Color fundus image — 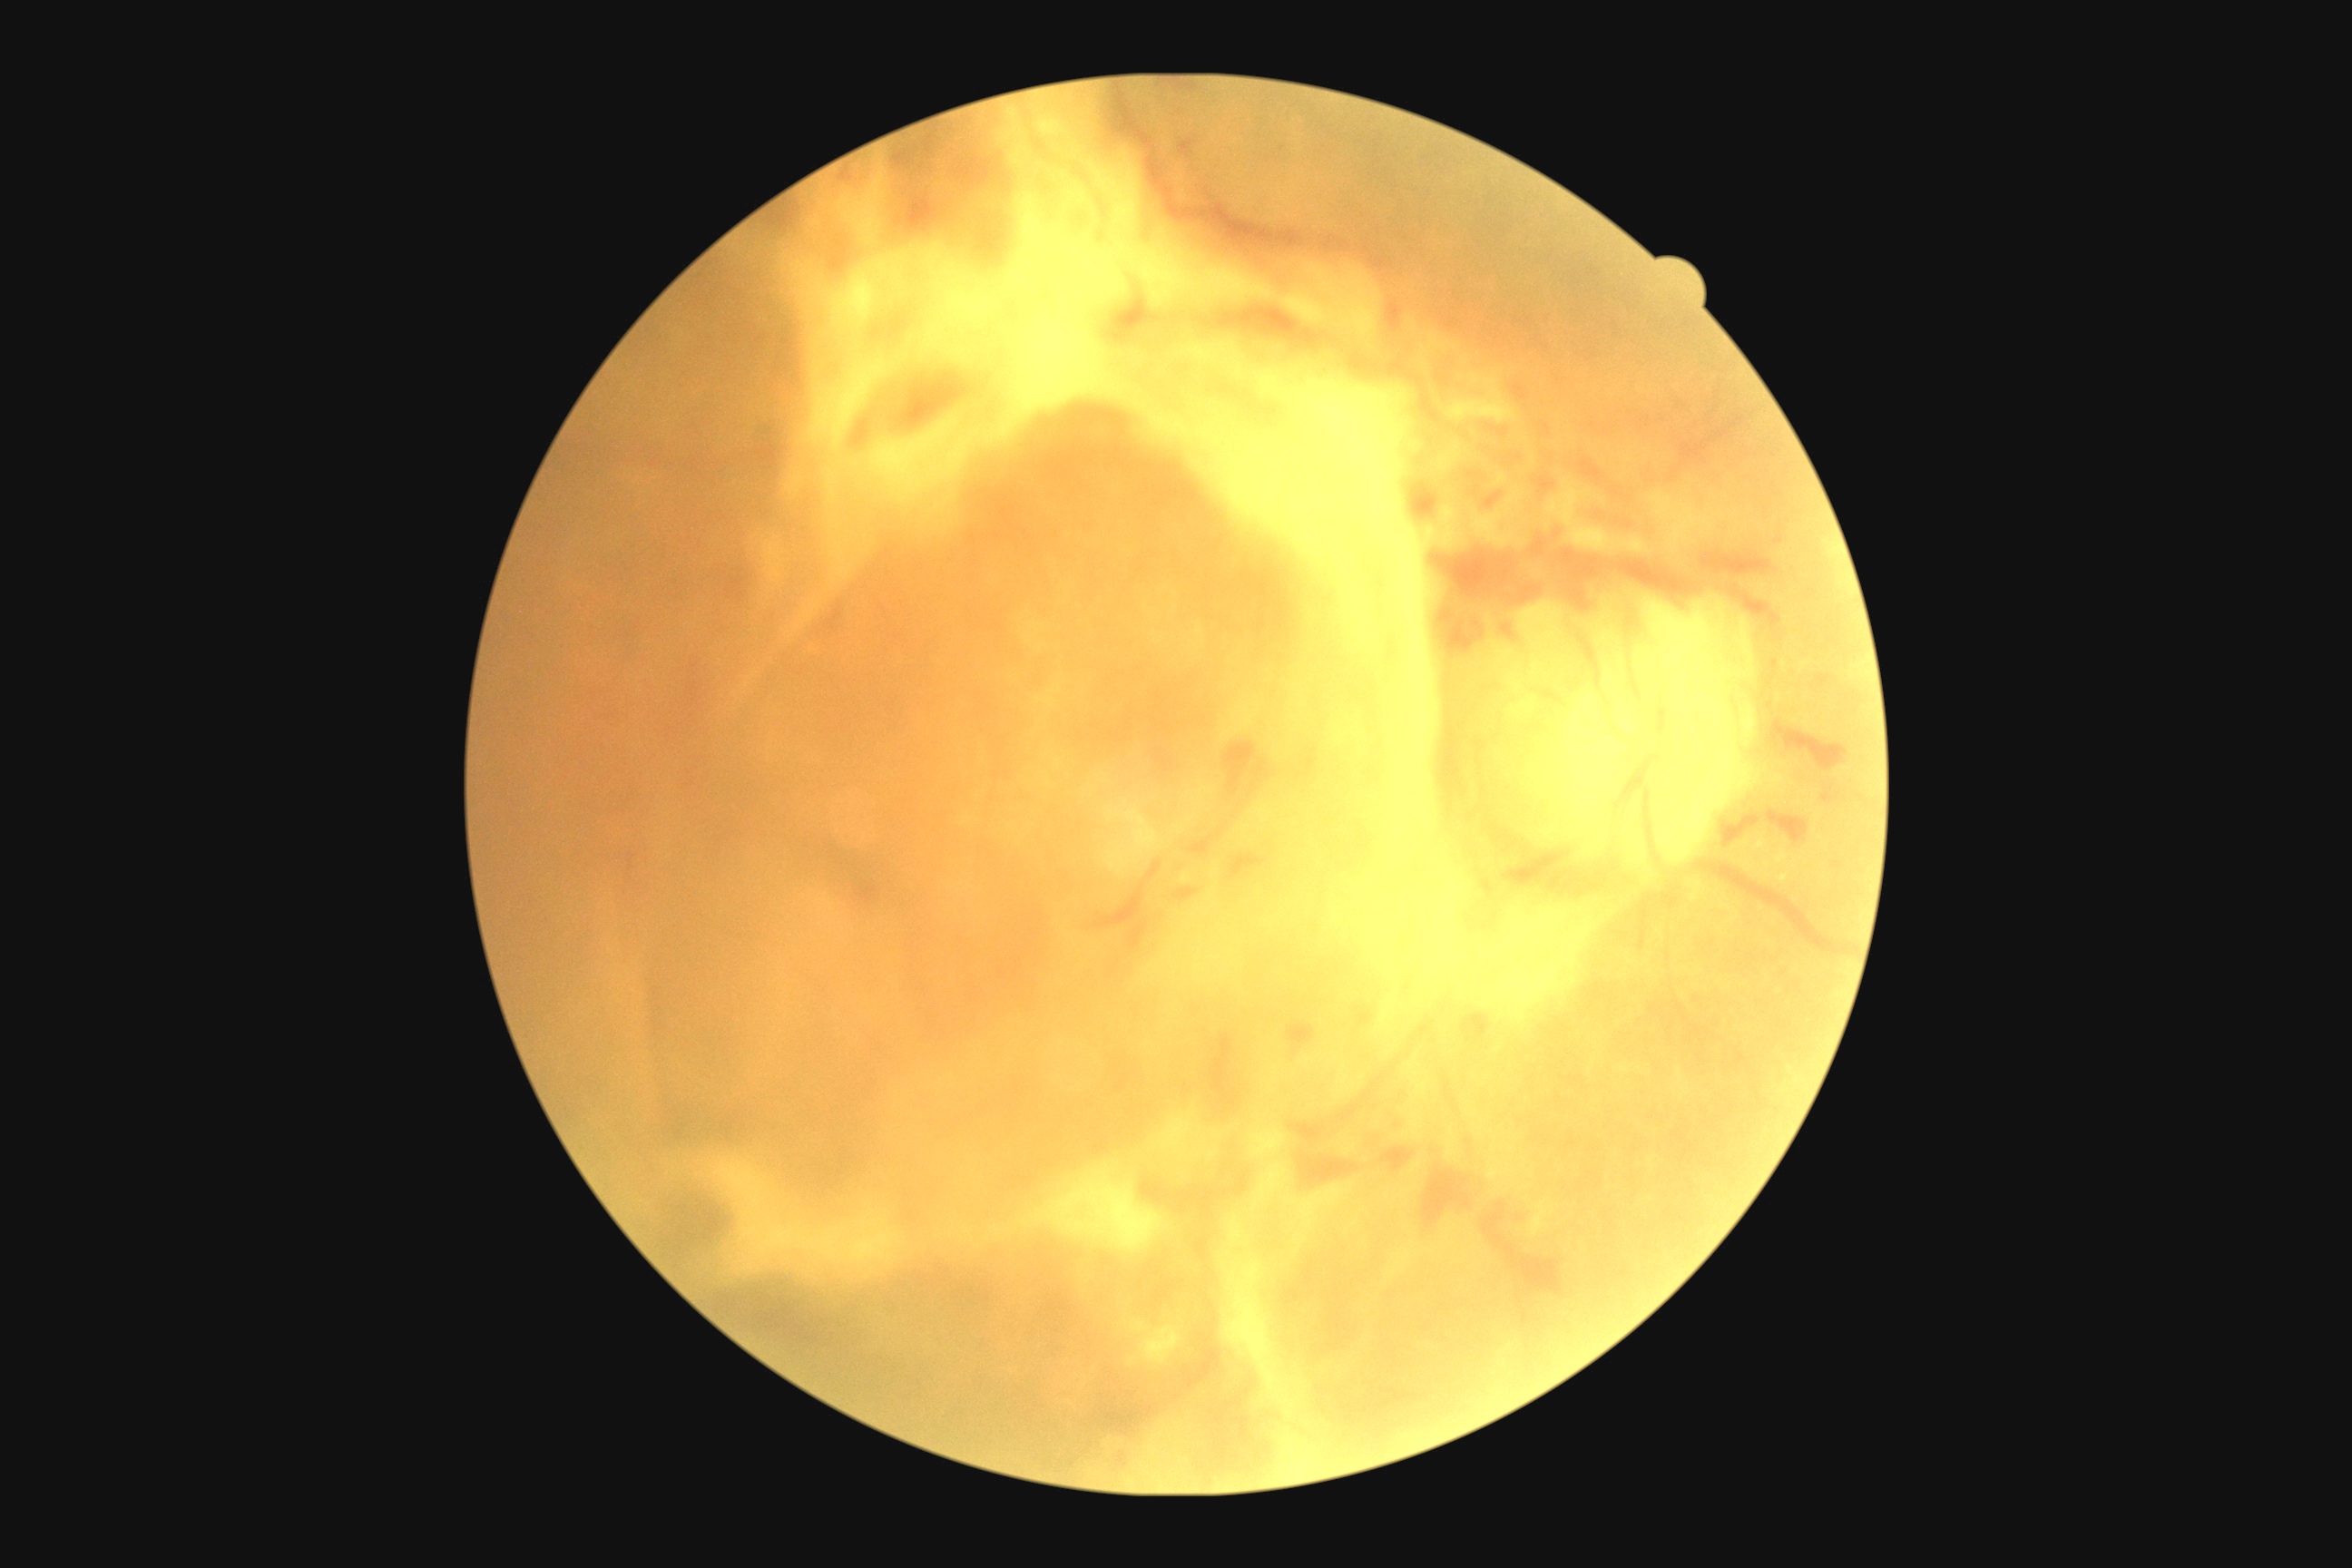

Diabetic retinopathy severity: PDR (grade 4).